45° FOV; retinal fundus photograph; image size 2352x1568 — 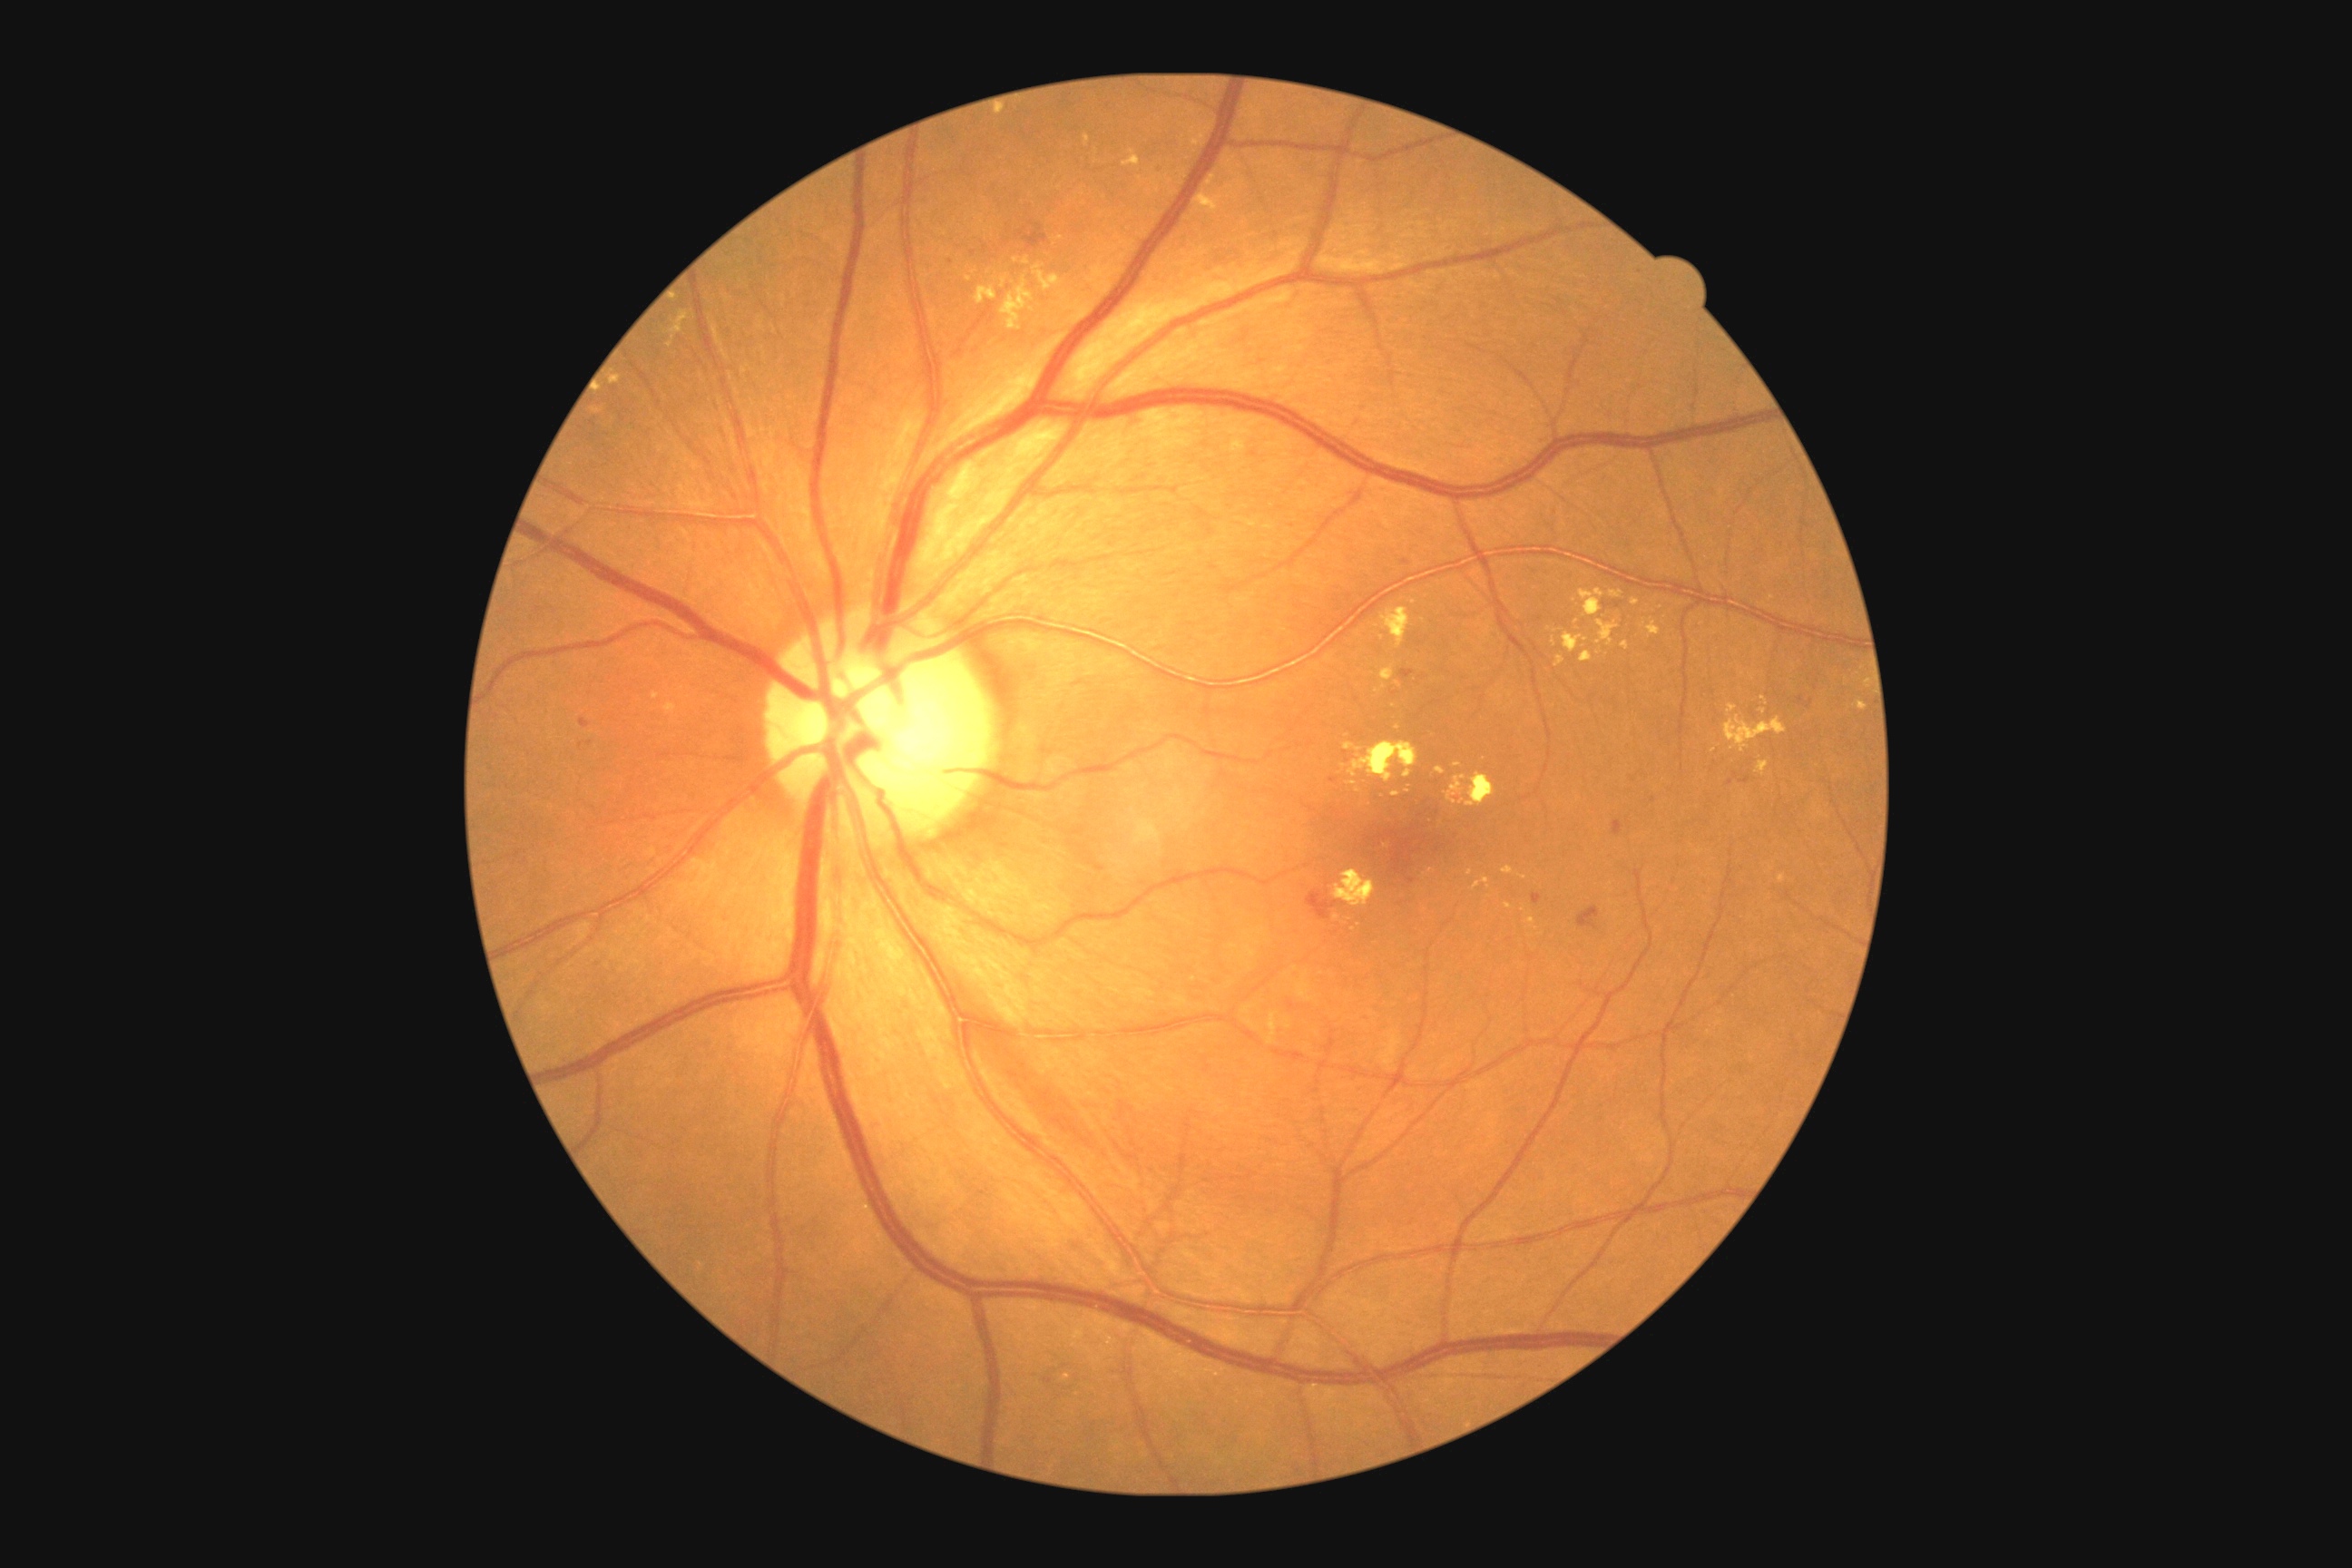
DR stage: moderate non-proliferative diabetic retinopathy (grade 2) — more than just microaneurysms but less than severe NPDR.
EXs include those at region(1473, 877, 1491, 890); region(1001, 277, 1035, 331); region(1193, 191, 1224, 215); region(1761, 698, 1769, 705); region(1859, 701, 1868, 710); region(1032, 264, 1064, 291); region(1580, 651, 1592, 663); region(1642, 618, 1661, 638); region(1424, 868, 1433, 877); region(593, 407, 602, 415); region(1502, 867, 1514, 876).
Additional small EXs near x=1394, y=707; x=969, y=279; x=1066, y=297; x=1598, y=654; x=1577, y=622; x=1344, y=767; x=1470, y=873.